FOV: 45 degrees:
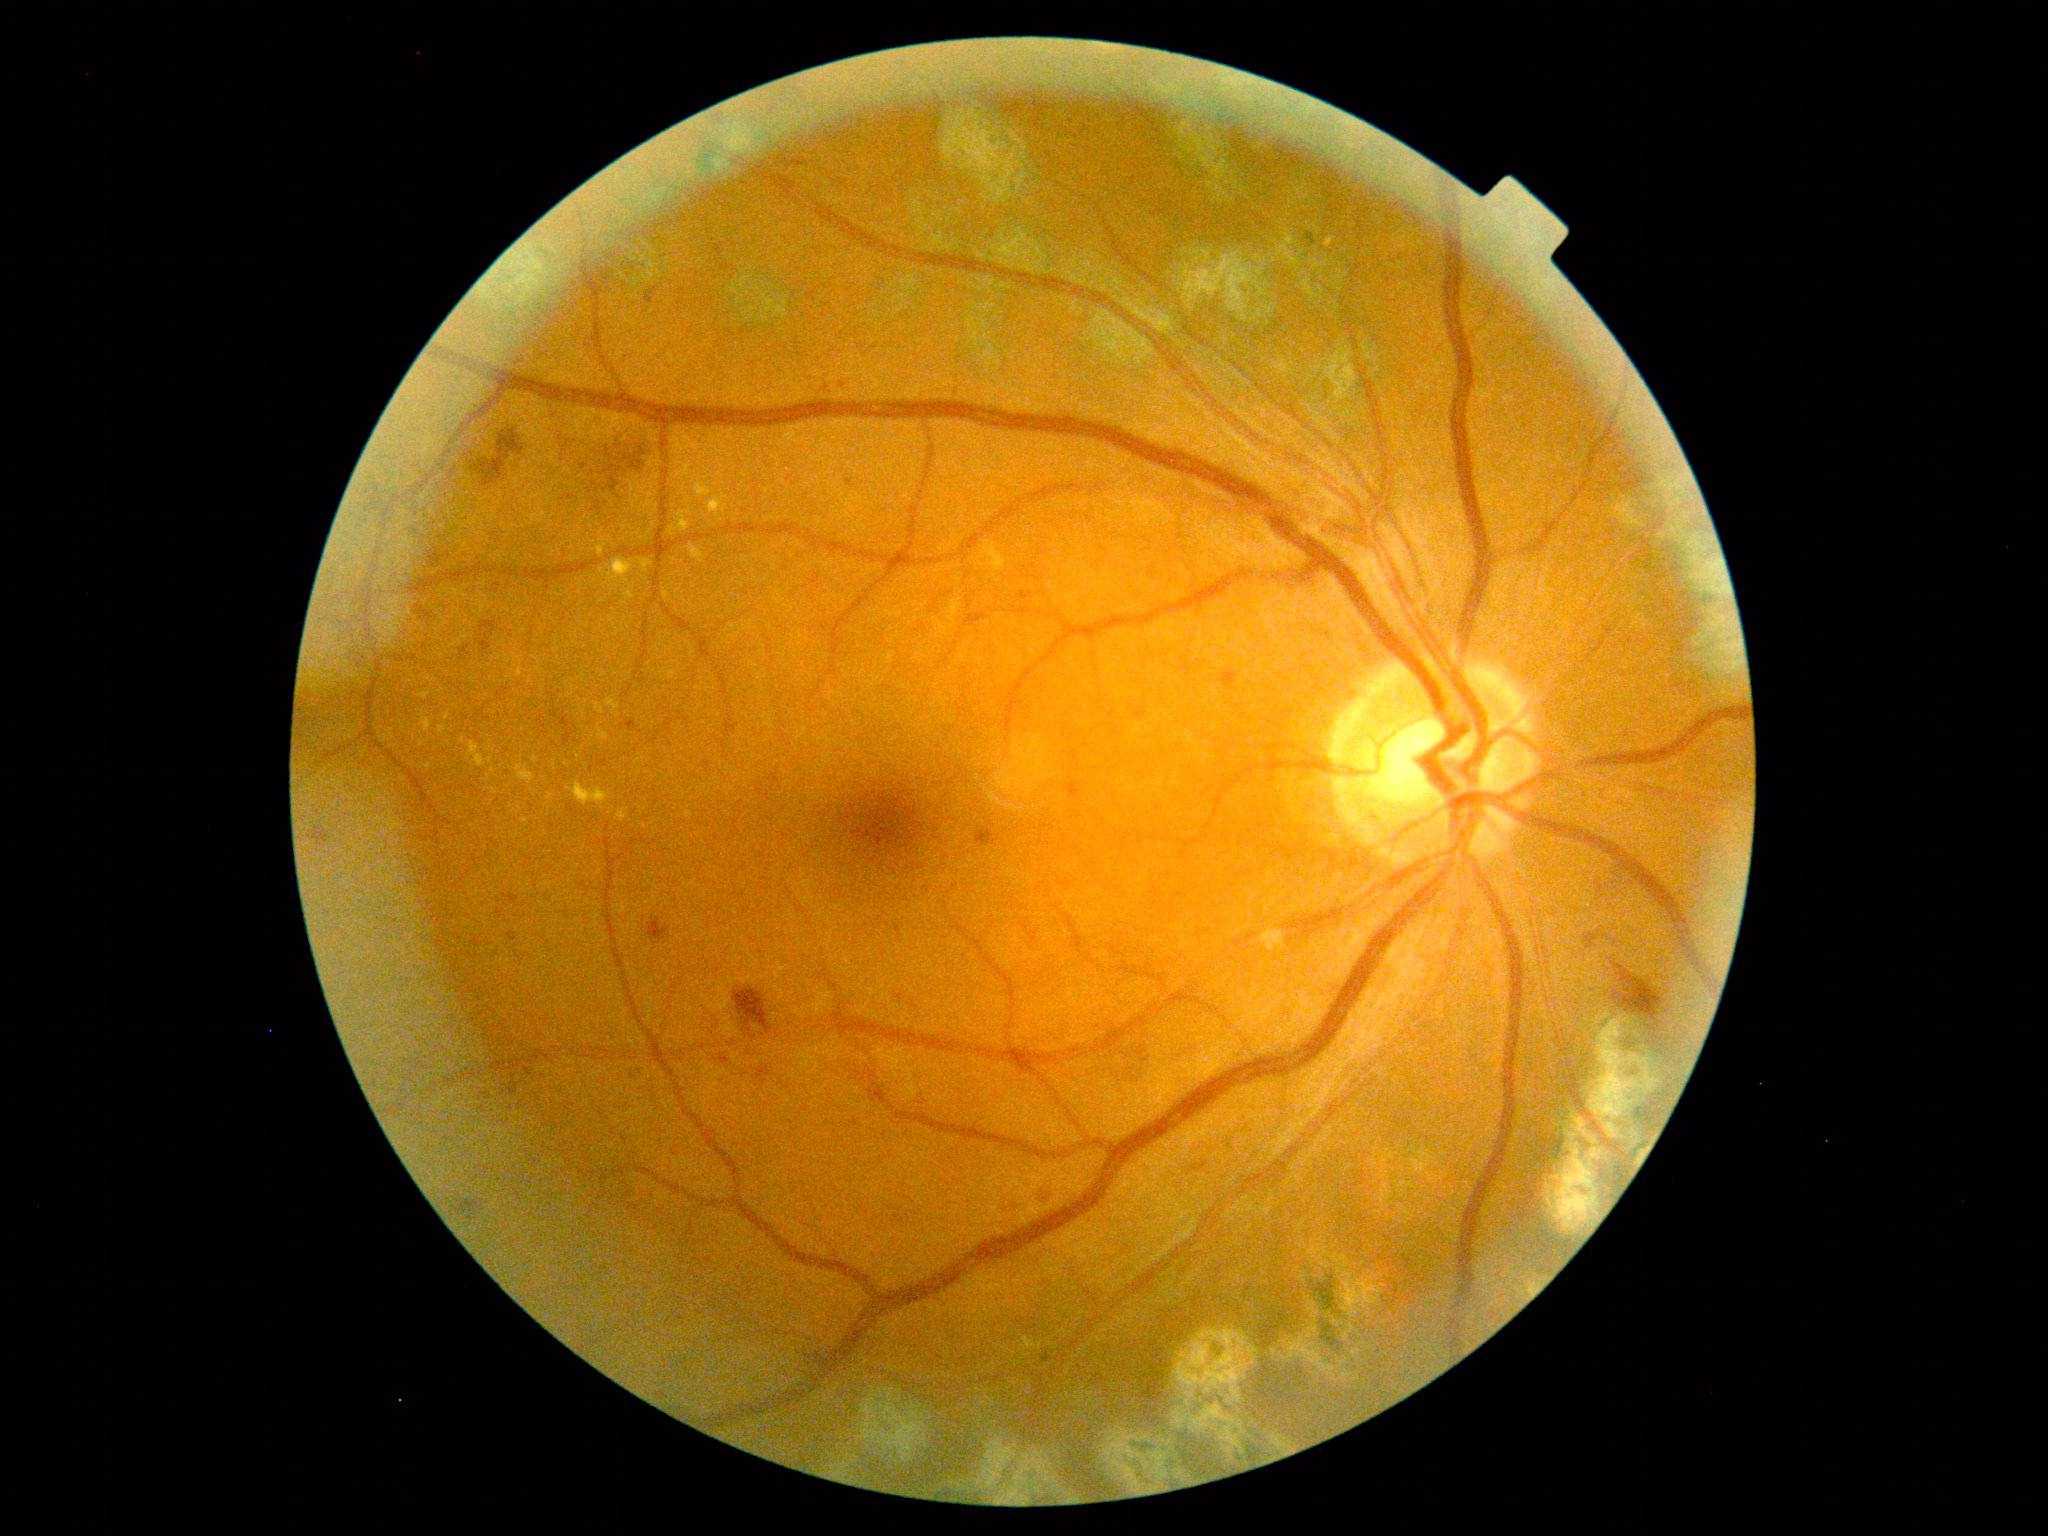 Diabetic retinopathy (DR): moderate NPDR (grade 2).
Hemorrhages (HEs) include x1=467, y1=429, x2=525, y2=487; x1=648, y1=917, x2=671, y2=943; x1=560, y1=713, x2=573, y2=747; x1=606, y1=448, x2=610, y2=456; x1=592, y1=501, x2=602, y2=511; x1=477, y1=640, x2=492, y2=652; x1=1135, y1=707, x2=1148, y2=723; x1=632, y1=460, x2=645, y2=471; x1=623, y1=449, x2=646, y2=462; x1=1219, y1=670, x2=1238, y2=691; x1=314, y1=826, x2=328, y2=843; x1=719, y1=1055, x2=731, y2=1063; x1=1122, y1=1048, x2=1151, y2=1081; x1=416, y1=604, x2=436, y2=620; x1=1586, y1=935, x2=1598, y2=949.
Additional small HEs near [560,439]; [585,467]; [617,446]; [593,473]; [499,694].